Davis DR grading — 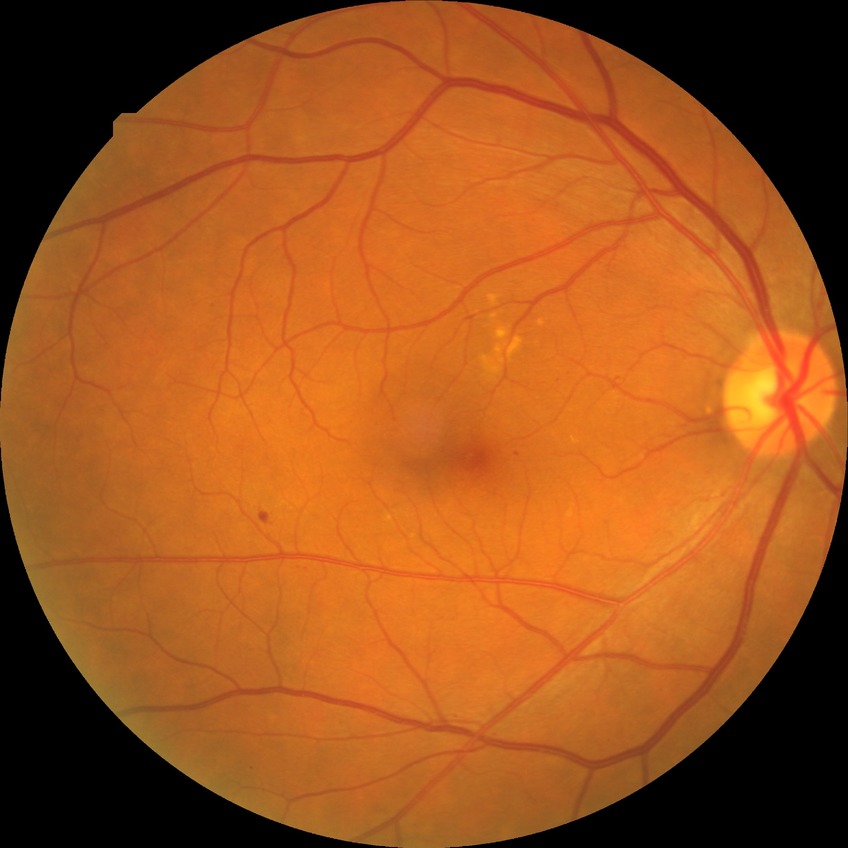 DR = NDR; DR impression = no DR findings.